Fundus photo taken with a portable handheld camera:
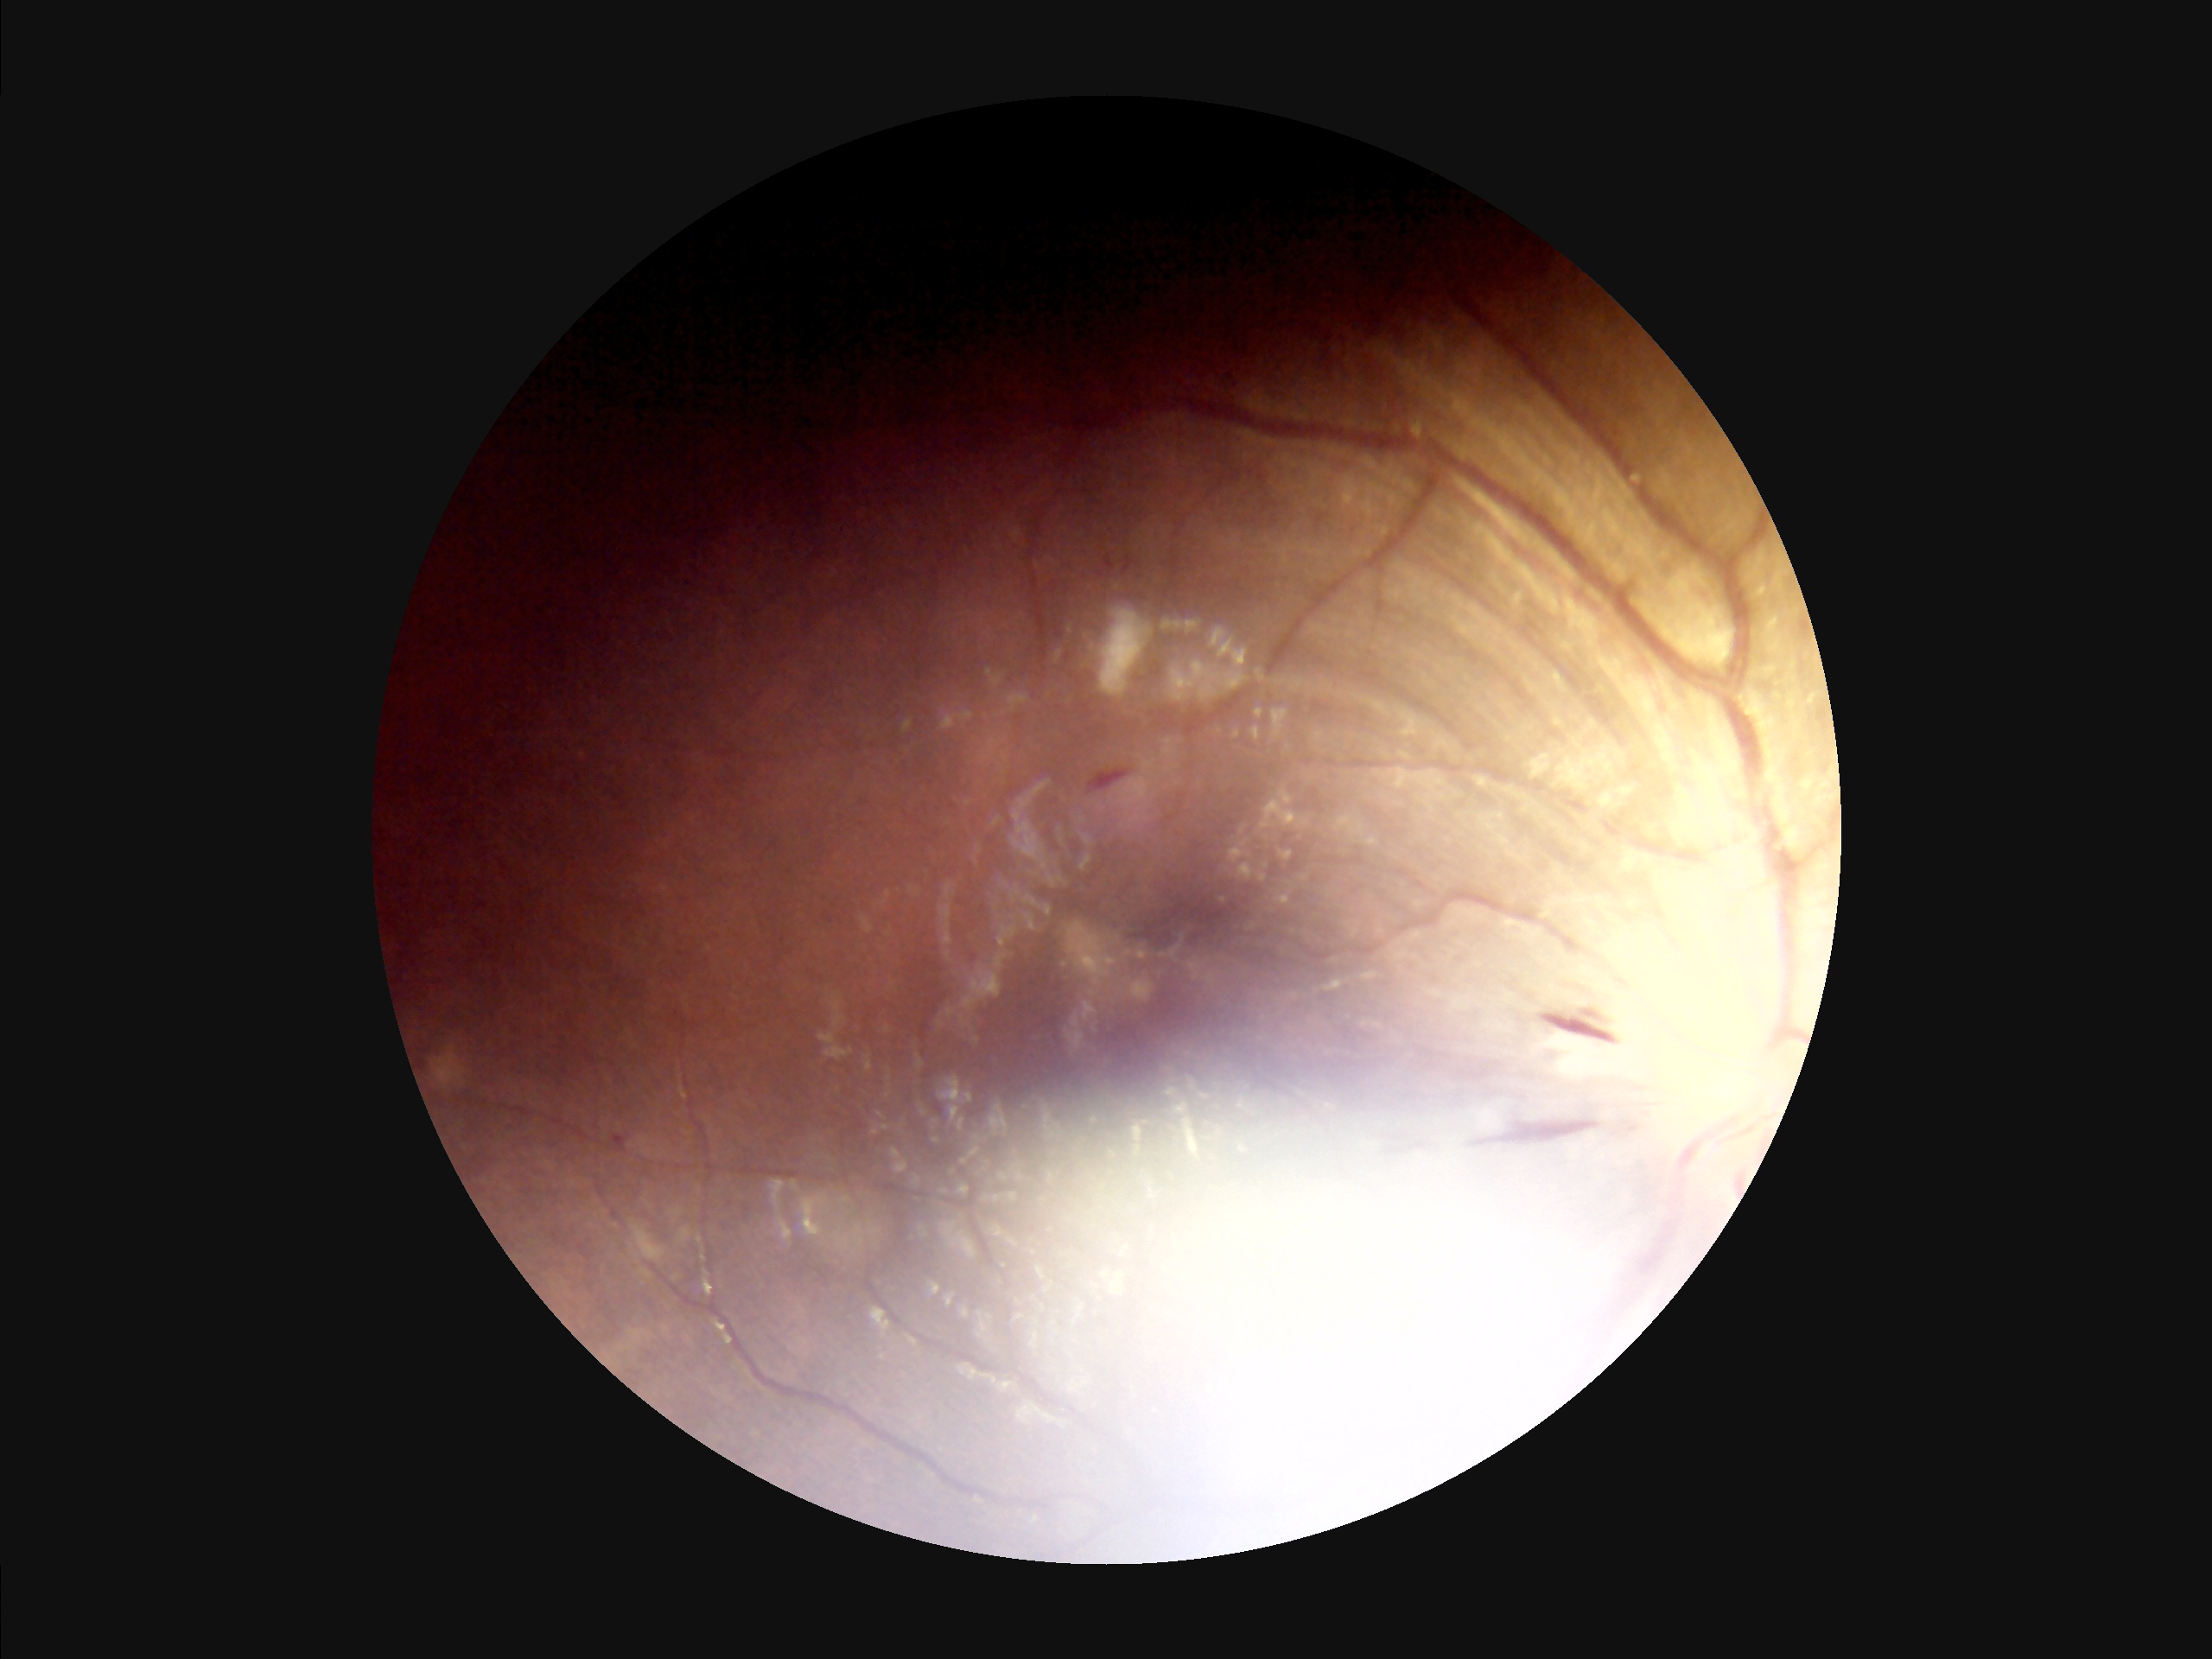 Contrast is low. Illumination and color are suboptimal. Noticeable blur in the optic disc, vessels, or background. Image quality is suboptimal.